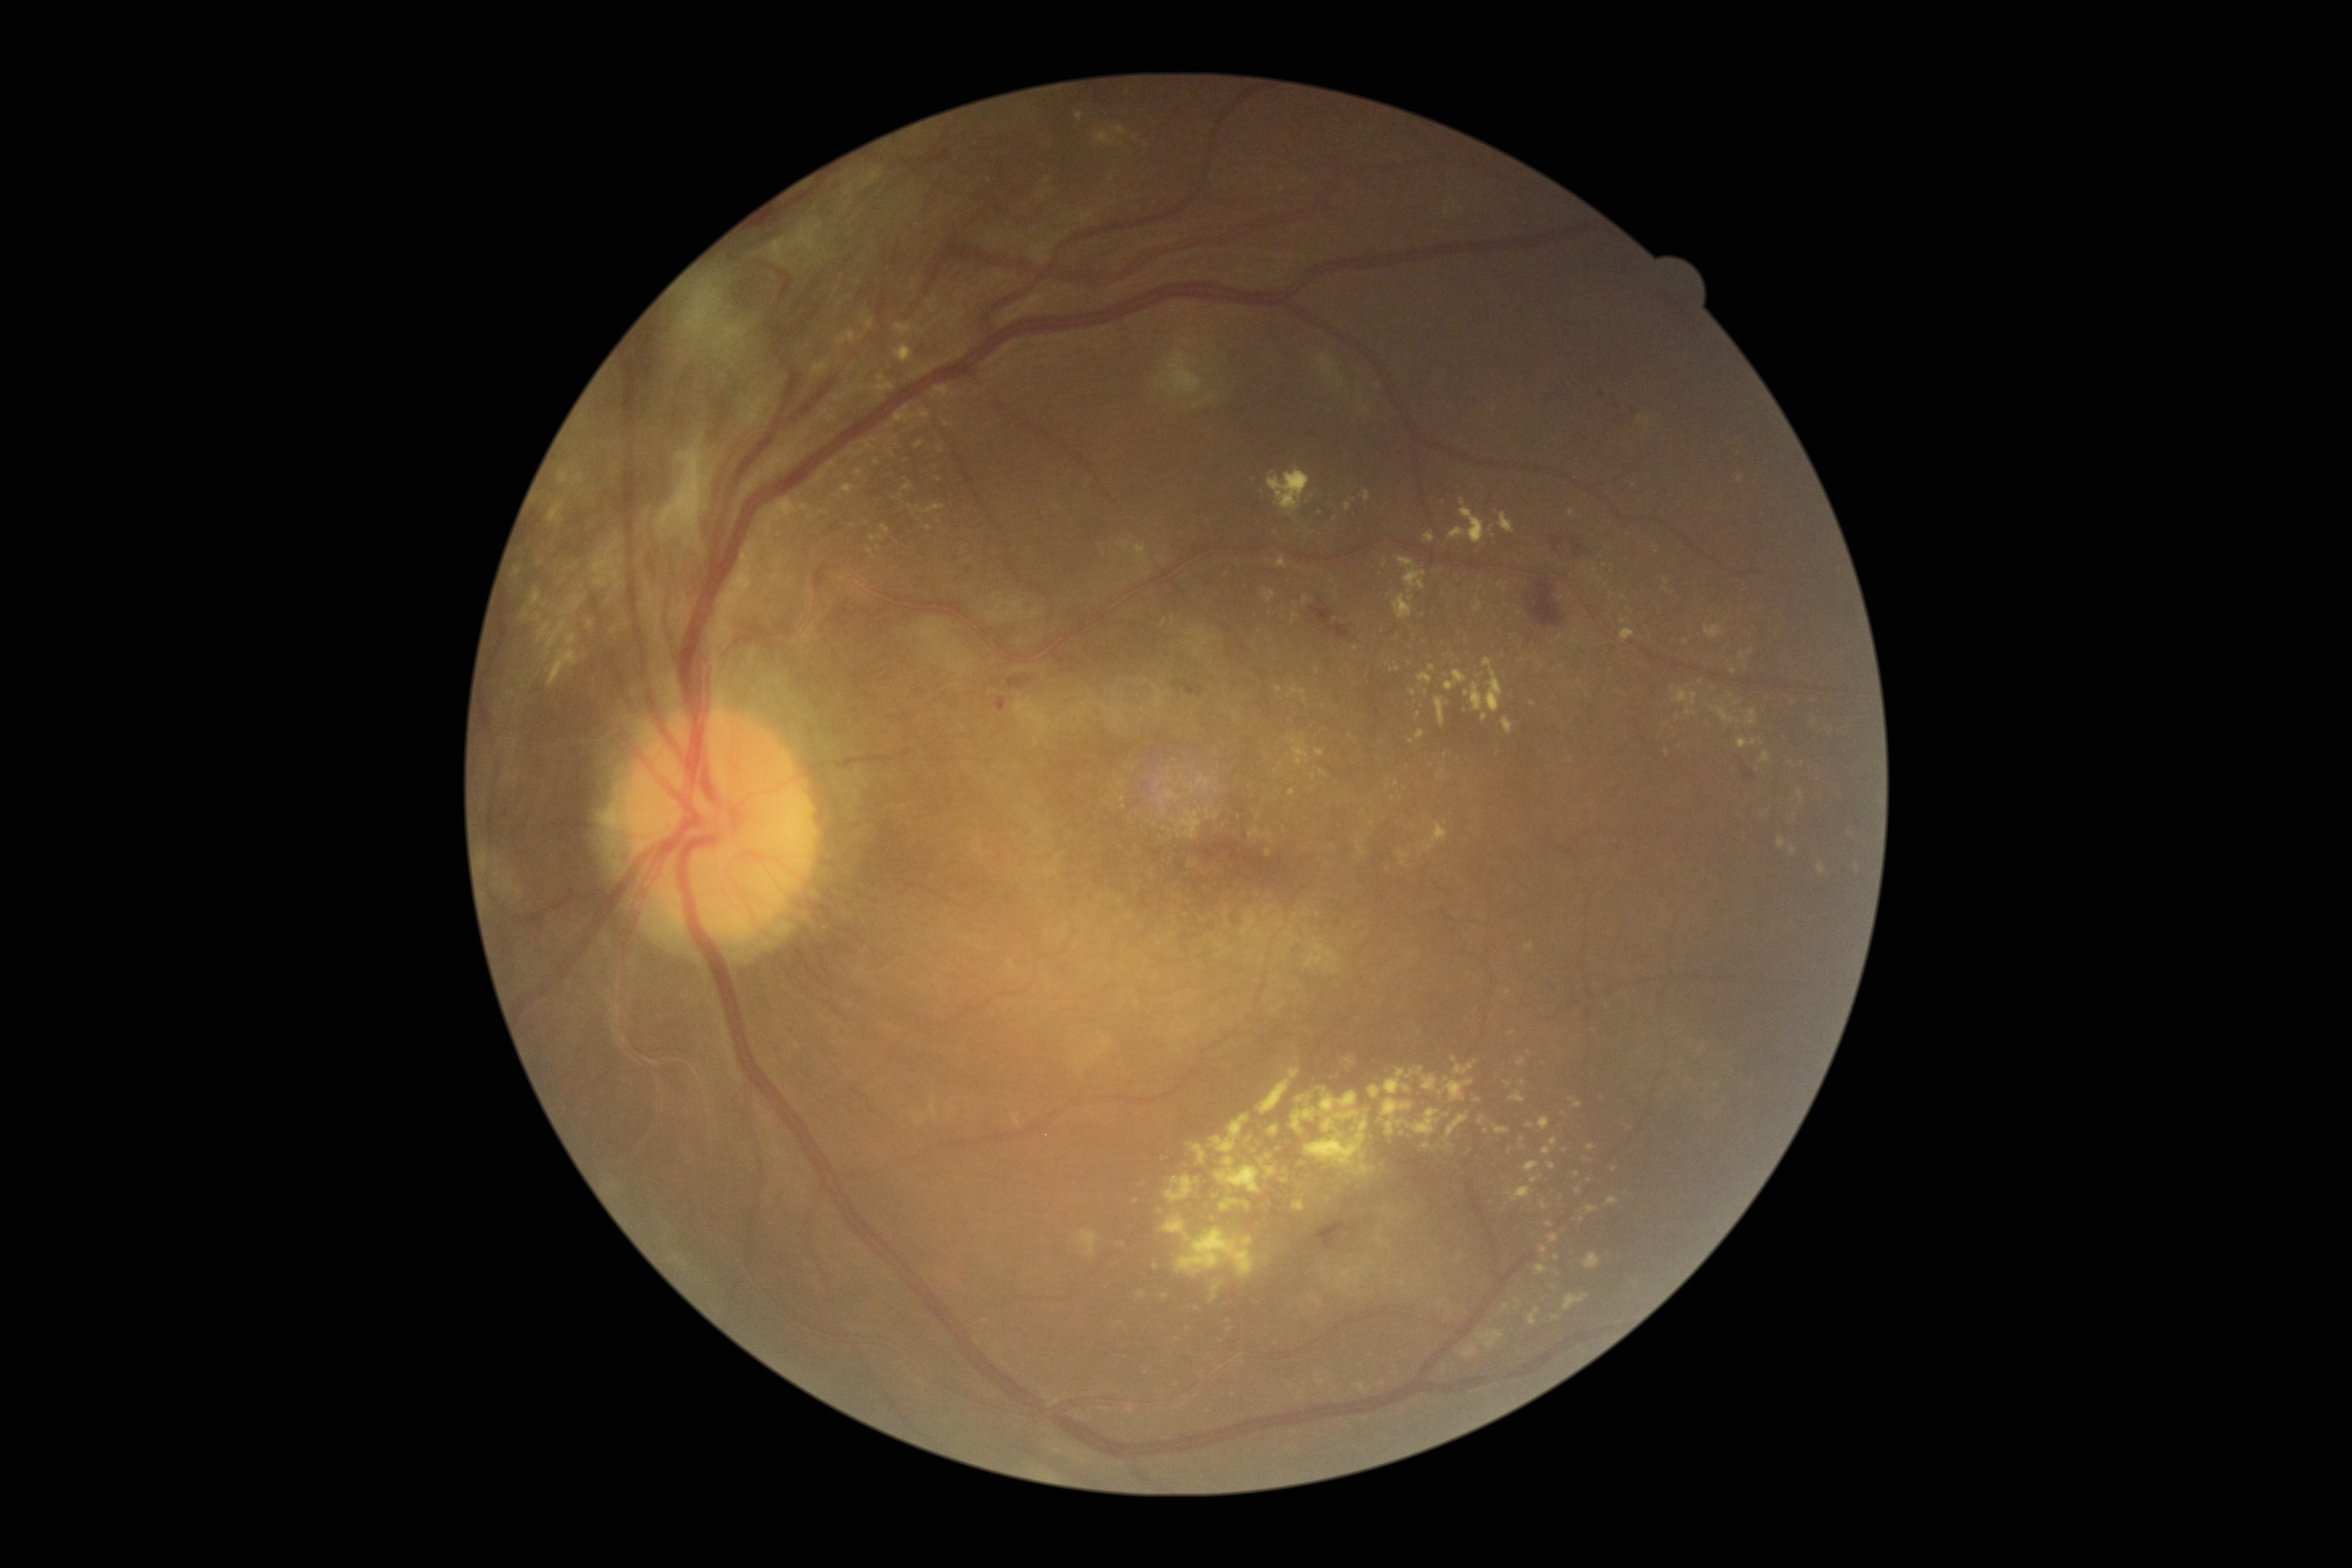

<lesions partial="true">
  <dr_grade>4</dr_grade>
  <ex partial="true">[left=1465, top=658, right=1503, bottom=712], [left=1406, top=1109, right=1440, bottom=1135], [left=1289, top=739, right=1310, bottom=765], [left=1315, top=750, right=1325, bottom=757], [left=1137, top=1289, right=1146, bottom=1300], [left=1276, top=557, right=1287, bottom=569], [left=1348, top=1163, right=1375, bottom=1177], [left=1790, top=845, right=1797, bottom=855], [left=1704, top=625, right=1723, bottom=638], [left=1502, top=718, right=1513, bottom=734]</ex>
  <ex_small>[1477, 1100], [836, 411], [1491, 529], [1431, 668], [1614, 1169], [1411, 599], [835, 418], [1383, 1383], [1625, 1193], [1736, 703]</ex_small>
</lesions>